Pediatric wide-field fundus photograph; 1240x1240 — 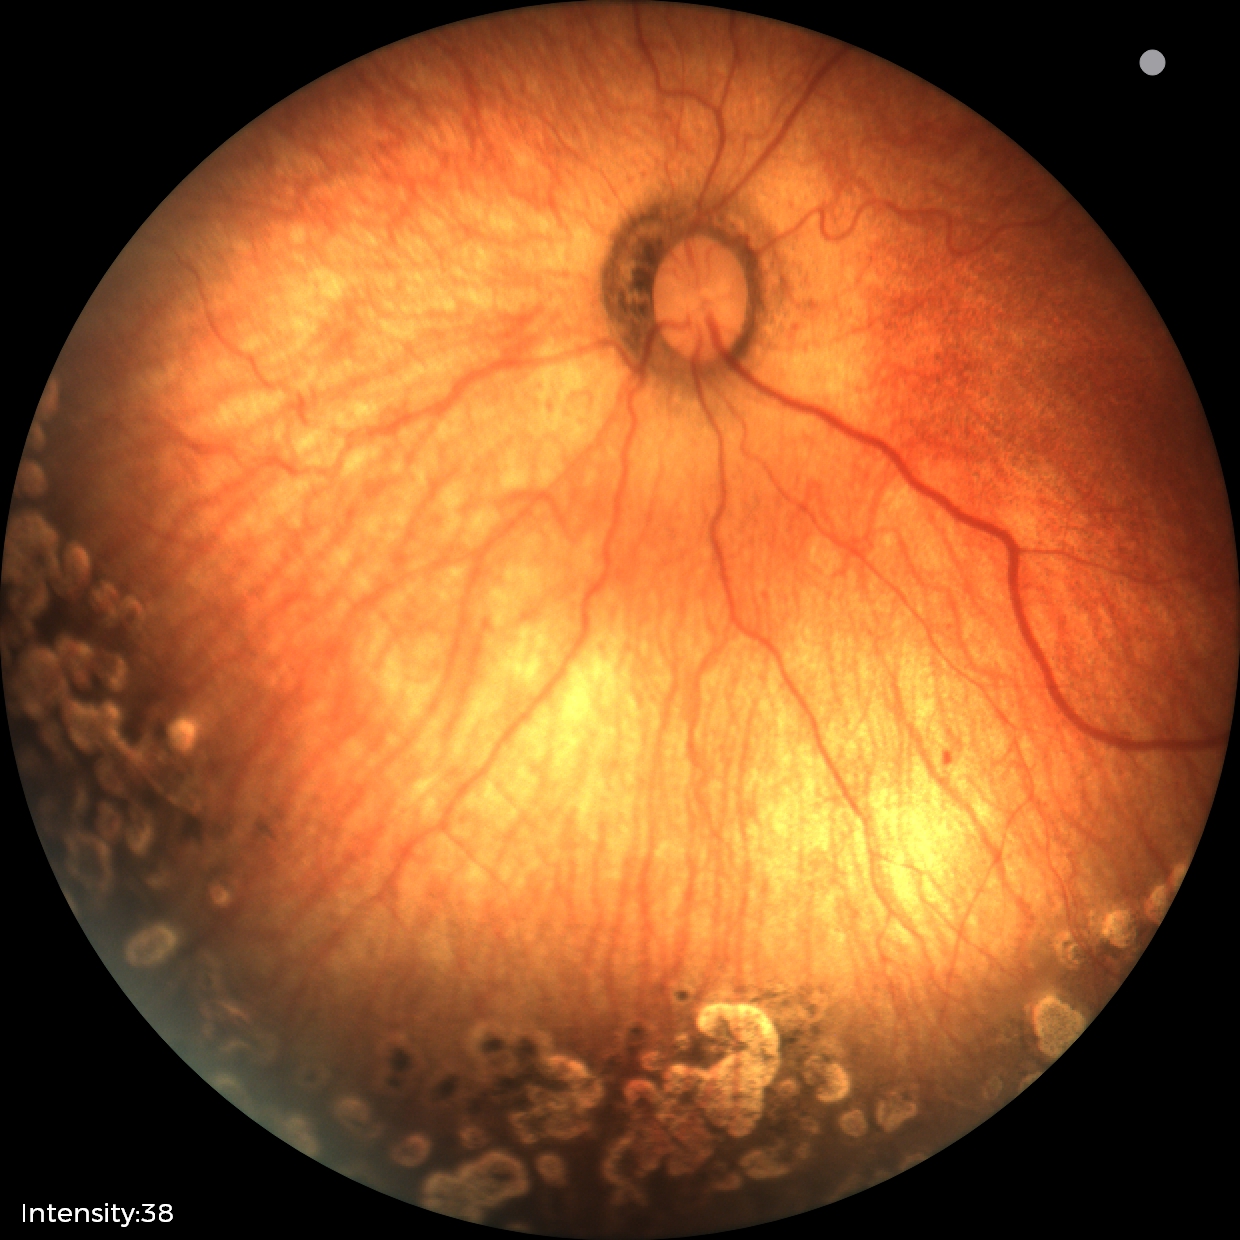

No plus disease.
Diagnosis from this screening exam: status post retinopathy of prematurity (ROP).